45° FOV:
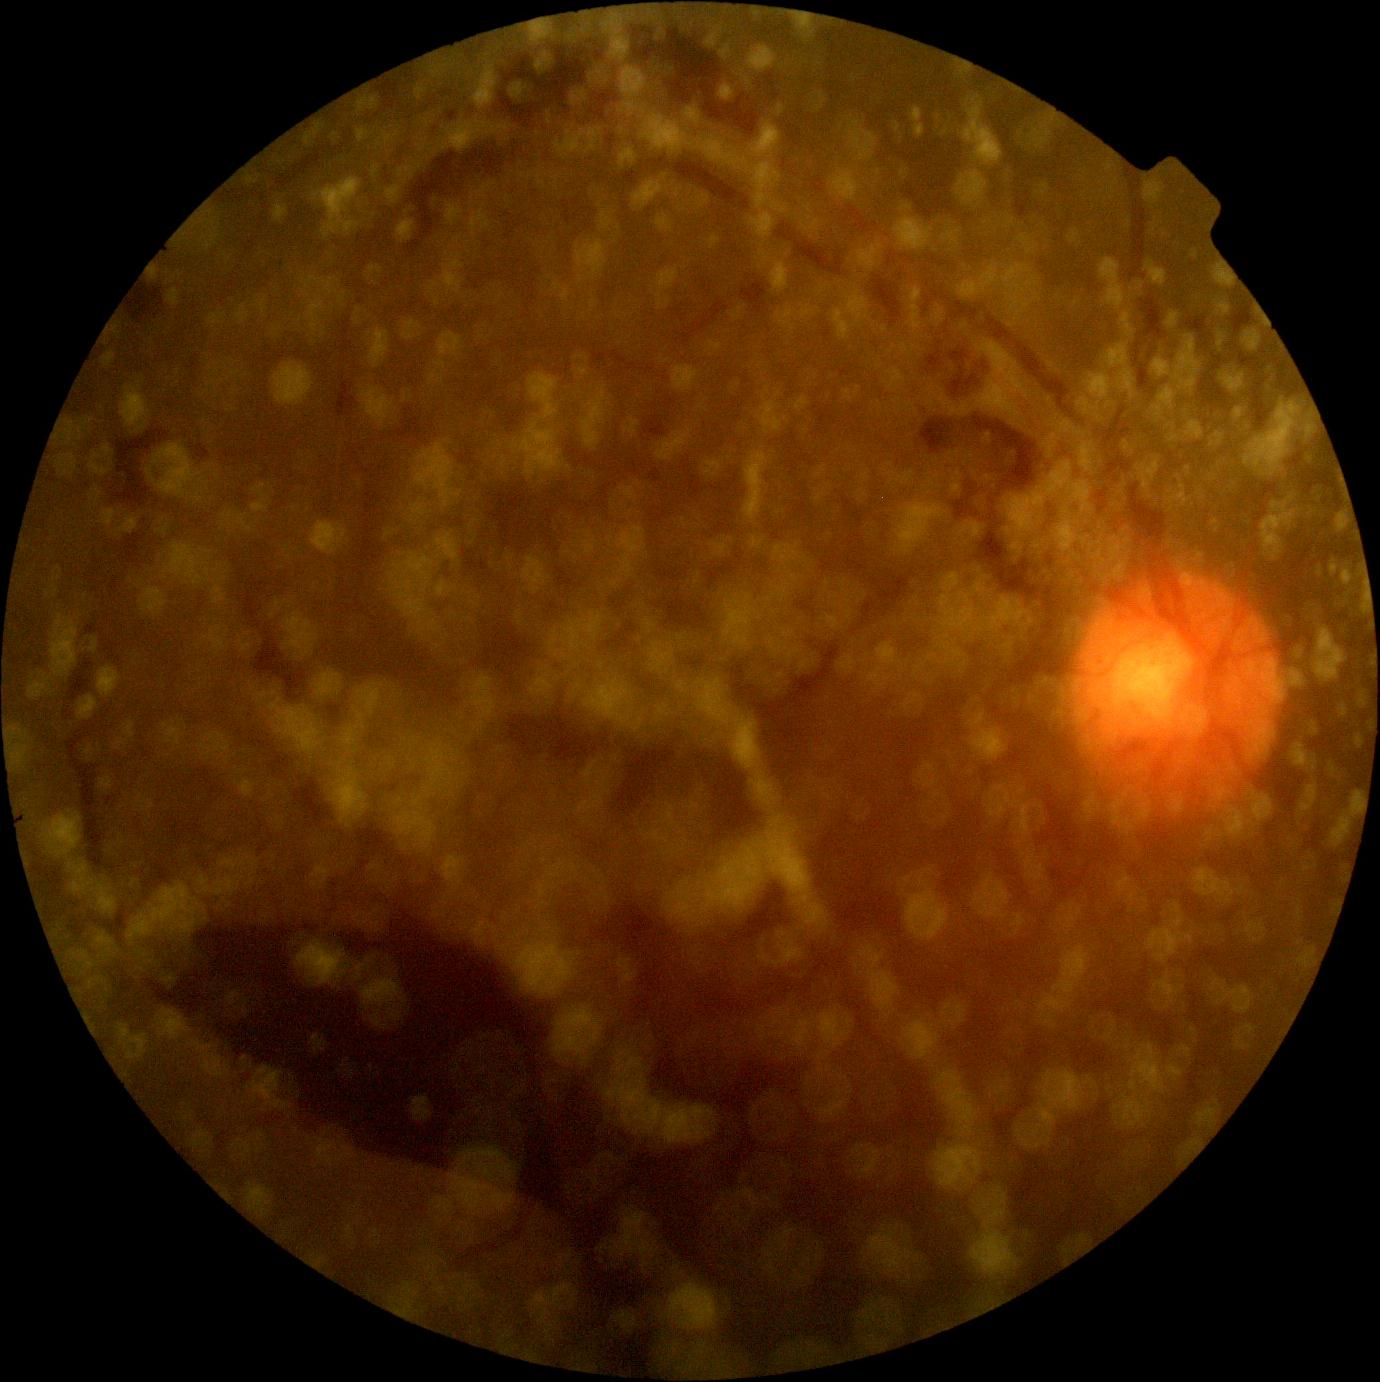

Diabetic retinopathy (DR): grade 4.